45° FOV; fundus photo
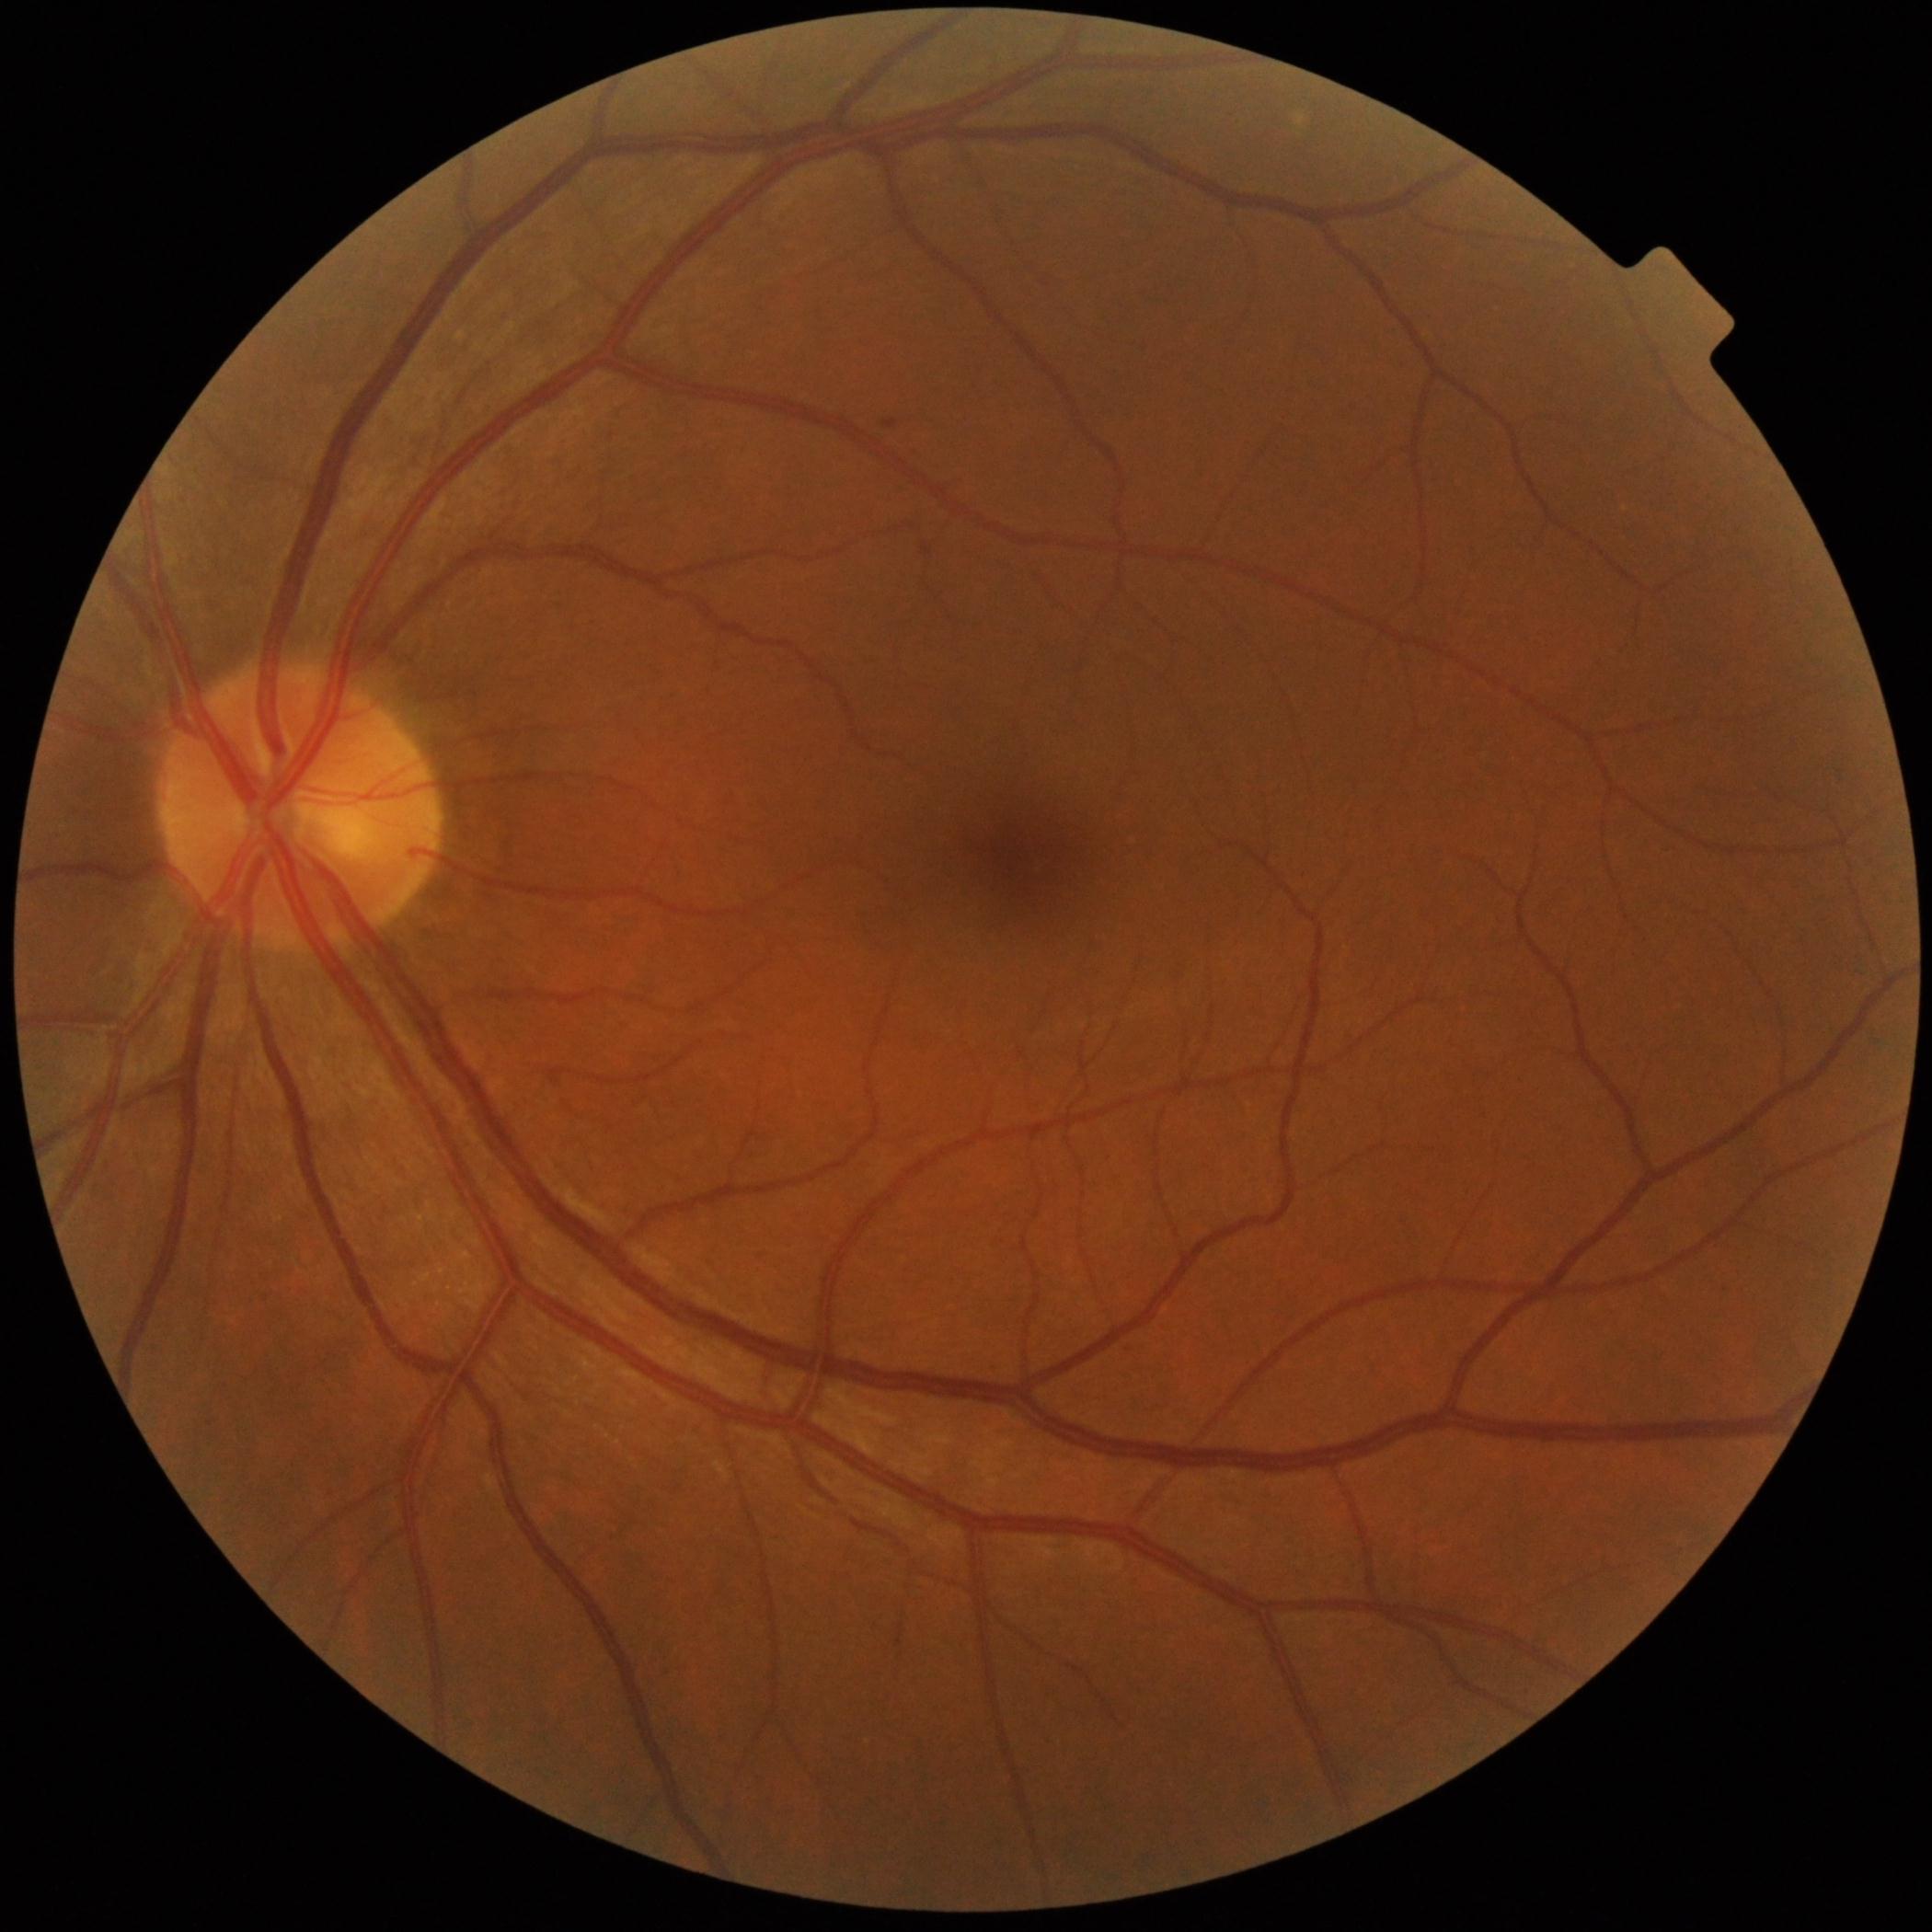 DR stage: grade 1.